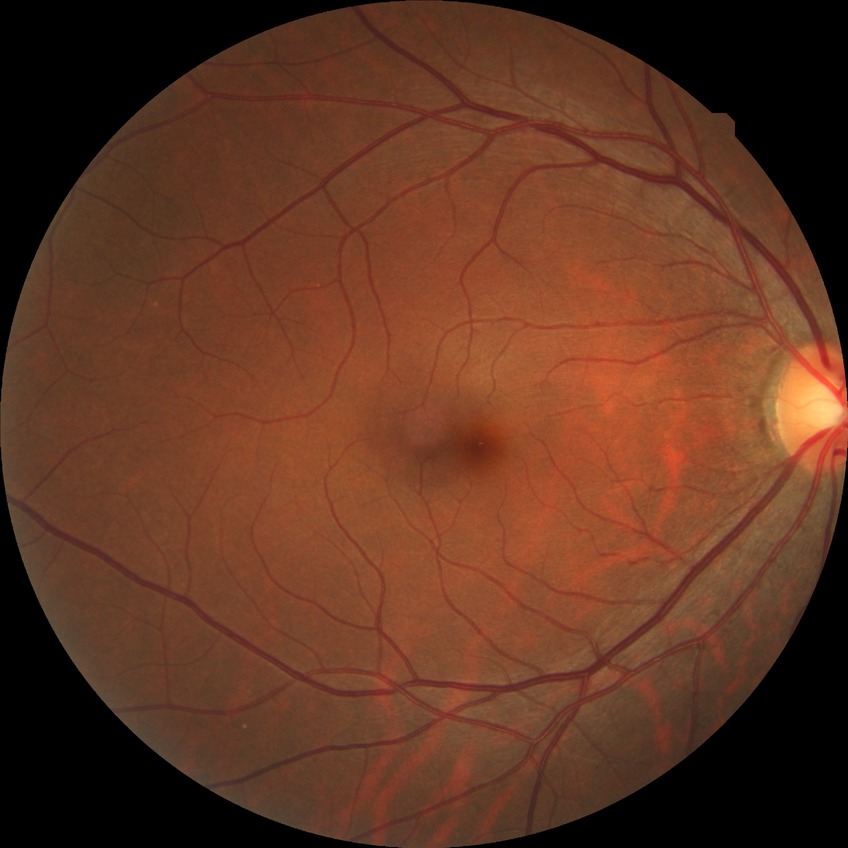 Annotations:
* Davis grading: no diabetic retinopathy